Wide-field contact fundus photograph of an infant; Clarity RetCam 3, 130° FOV; 640x480
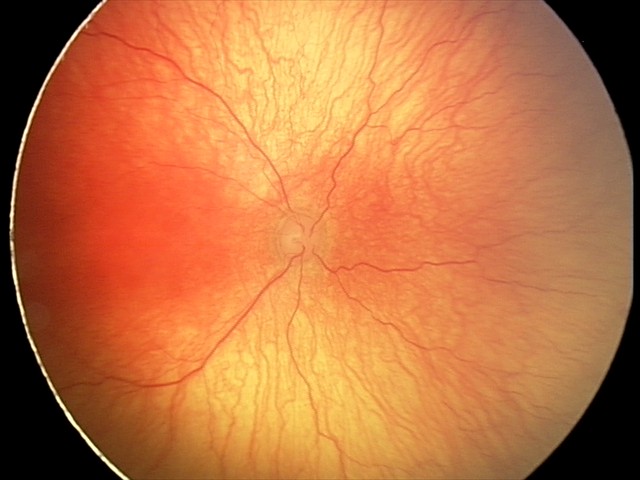

Screening diagnosis: aggressive ROP (A-ROP).